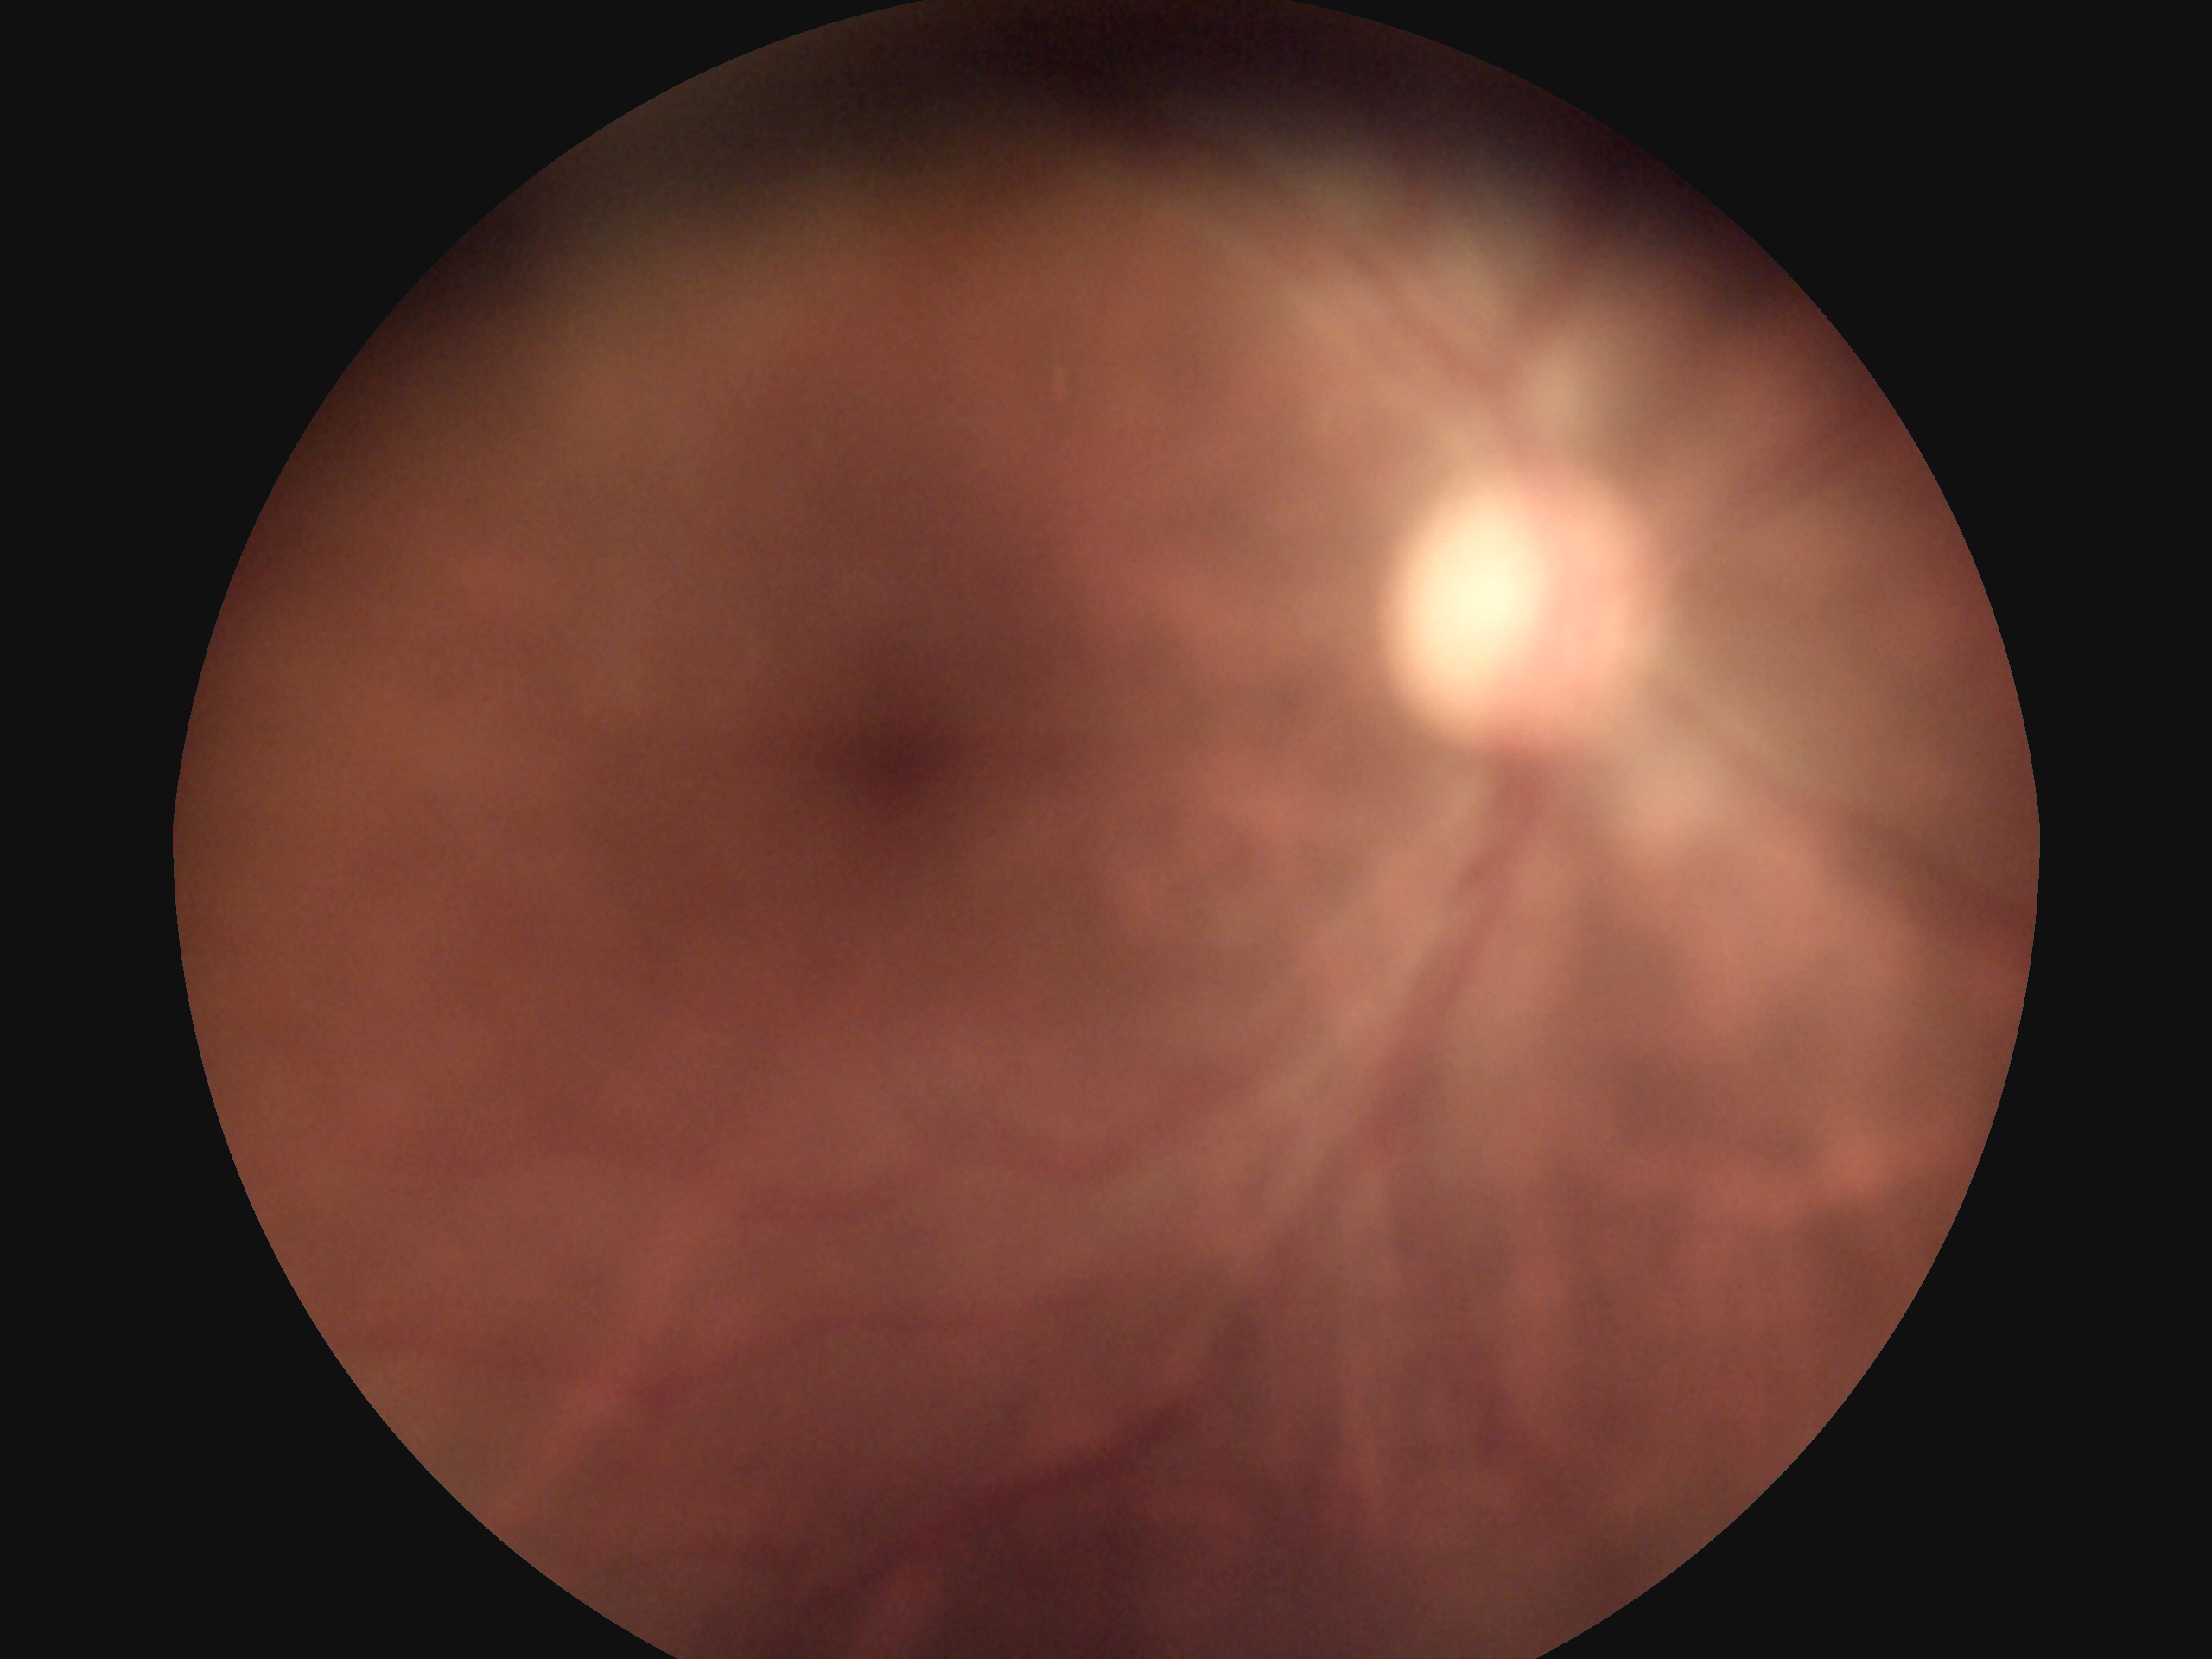
DR severity: 0/4.